CFP — 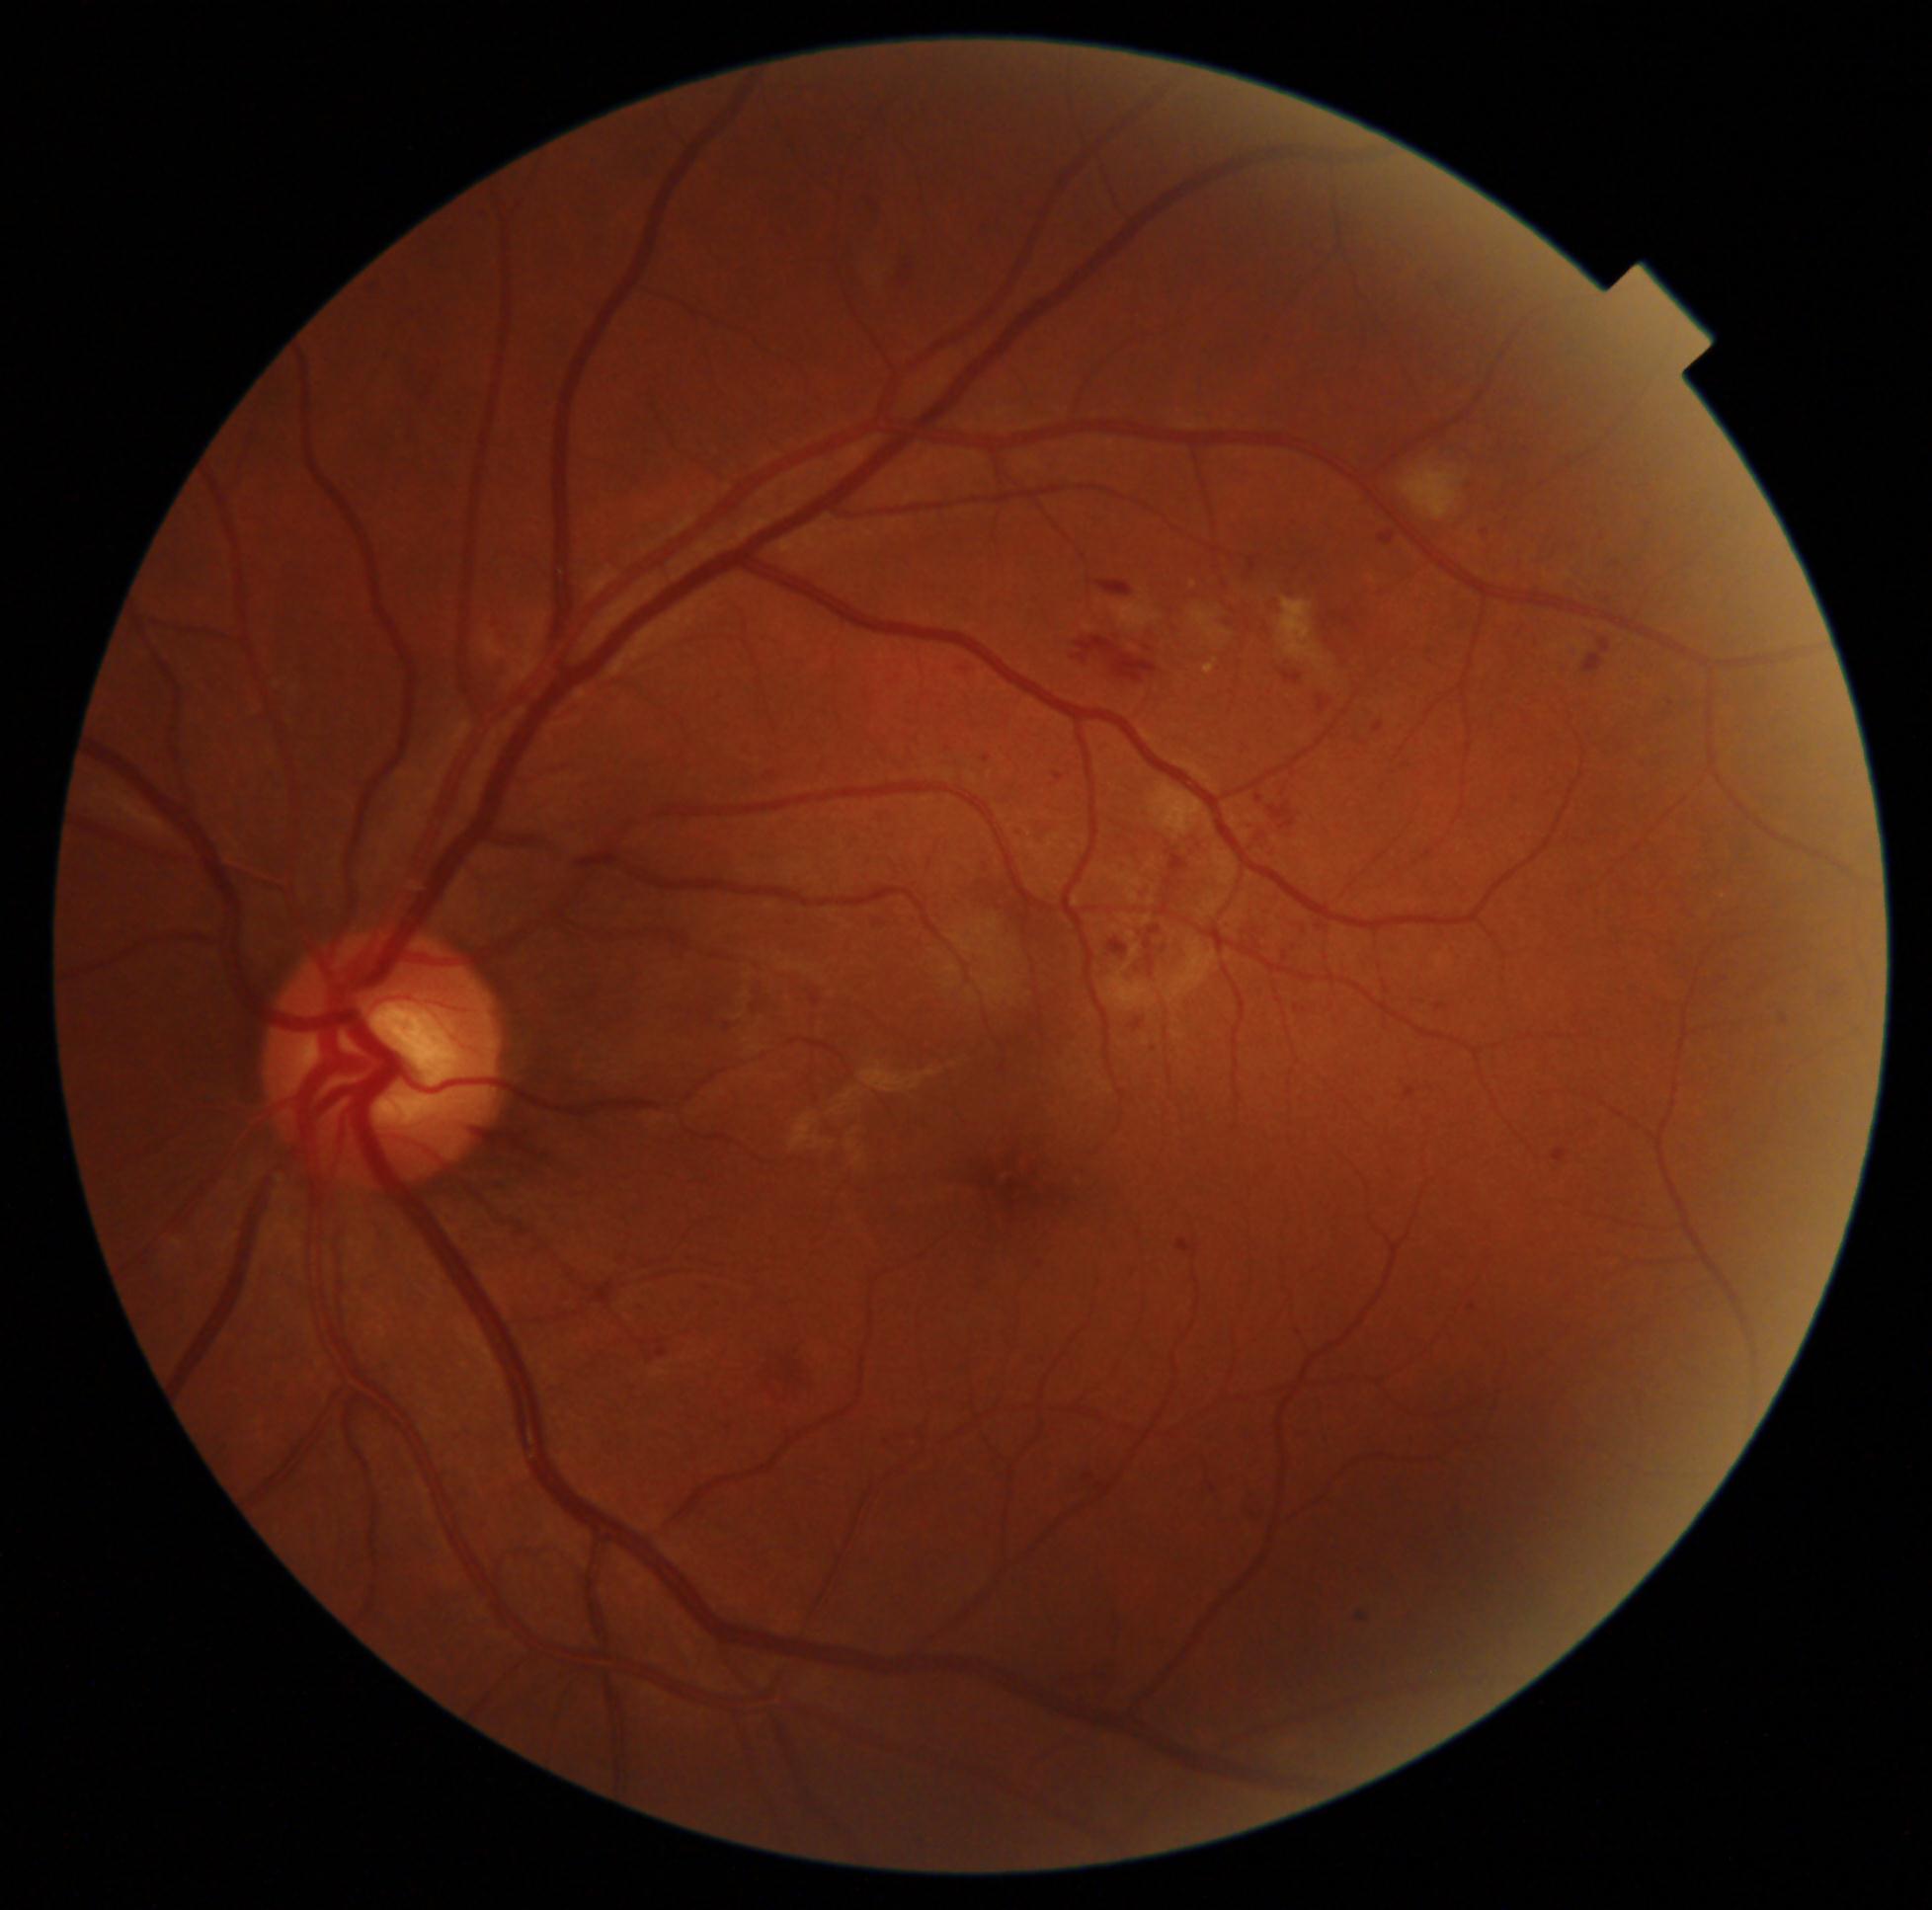 DR: grade 2 (moderate NPDR).